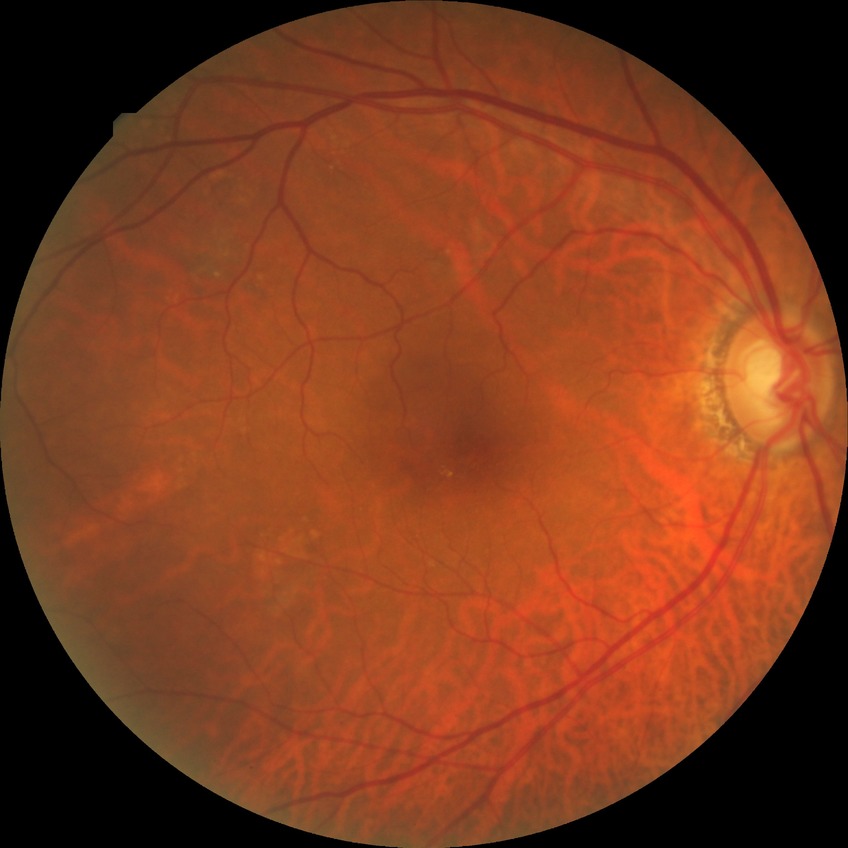
Diabetic retinopathy (DR): no diabetic retinopathy (NDR).